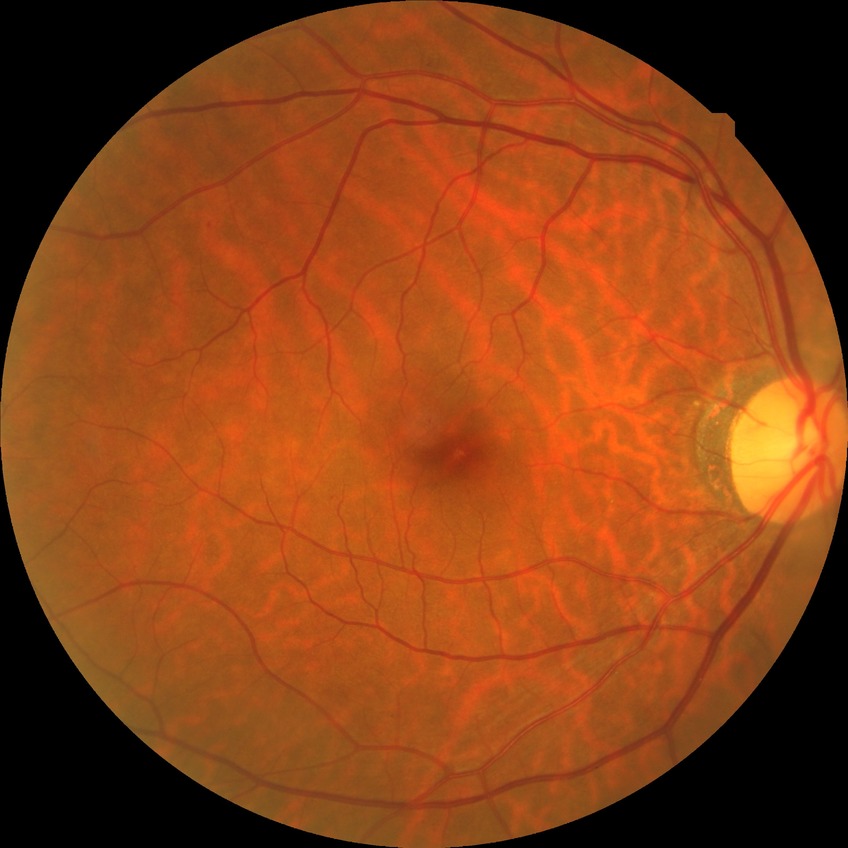

  davis_grade: no diabetic retinopathy (NDR)